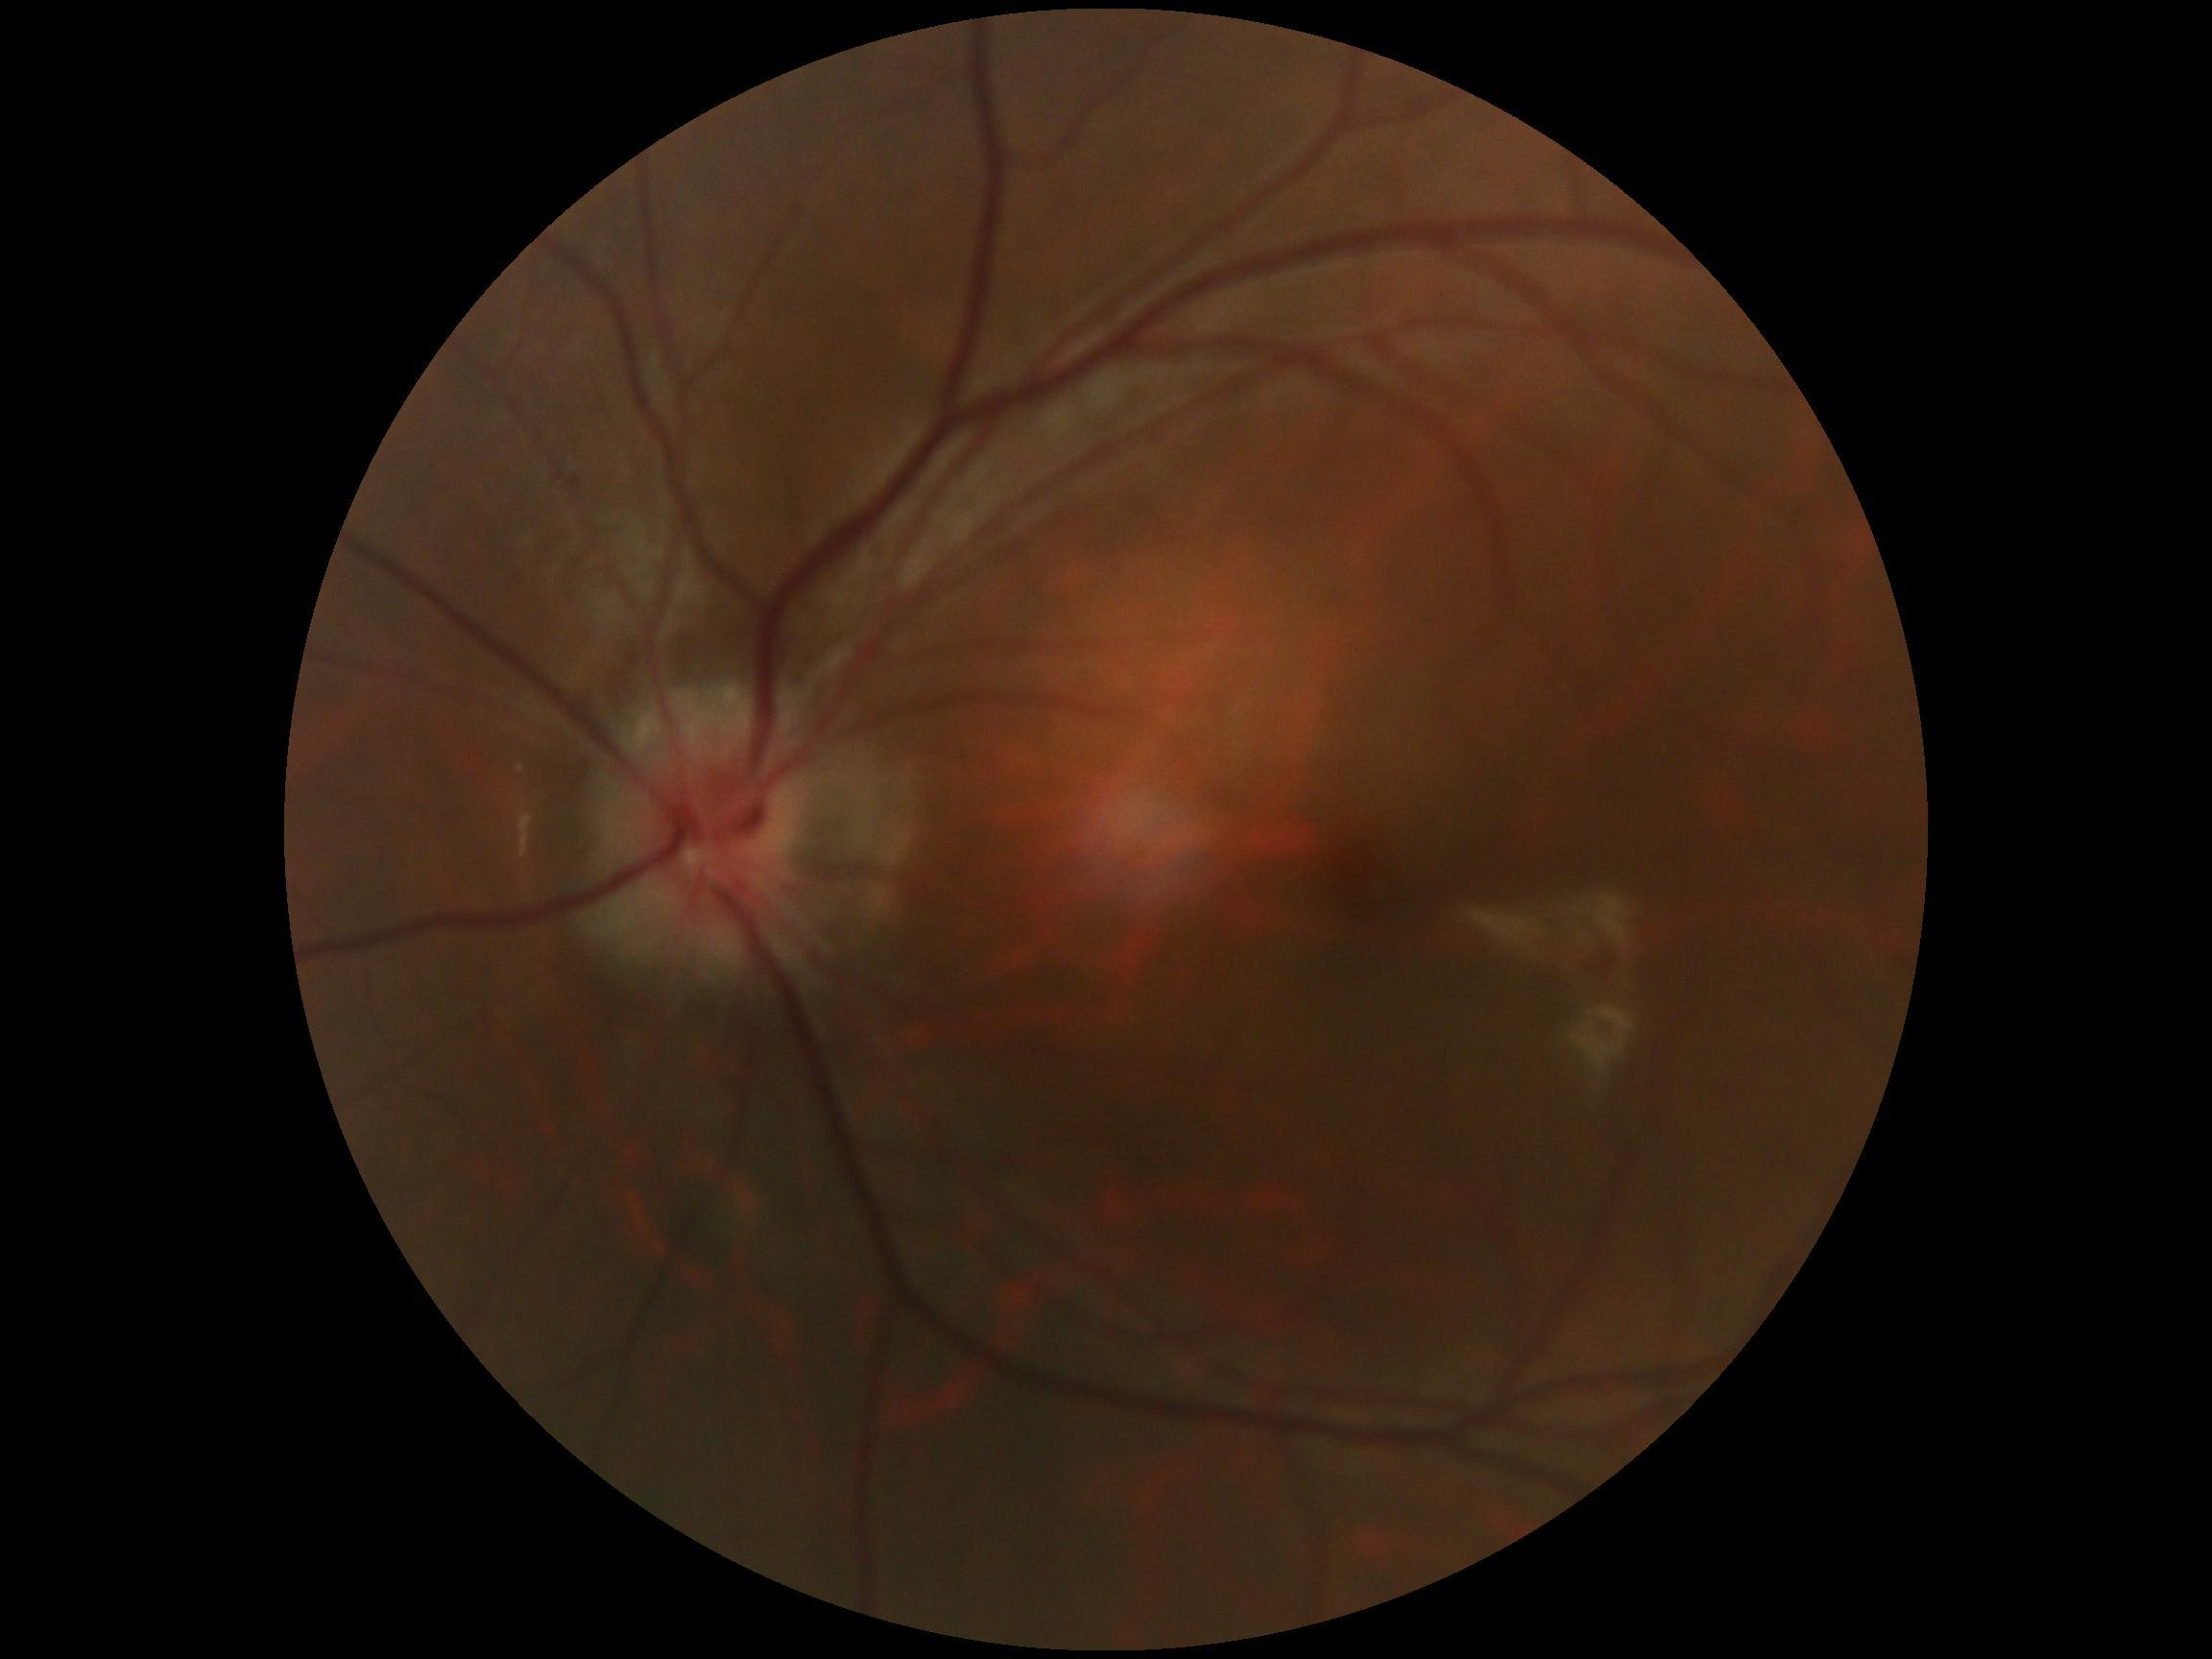
{
  "dr_grade": "no apparent retinopathy (0)",
  "dr_impression": "no apparent DR"
}